Color fundus image. 1932 by 1932 pixels — 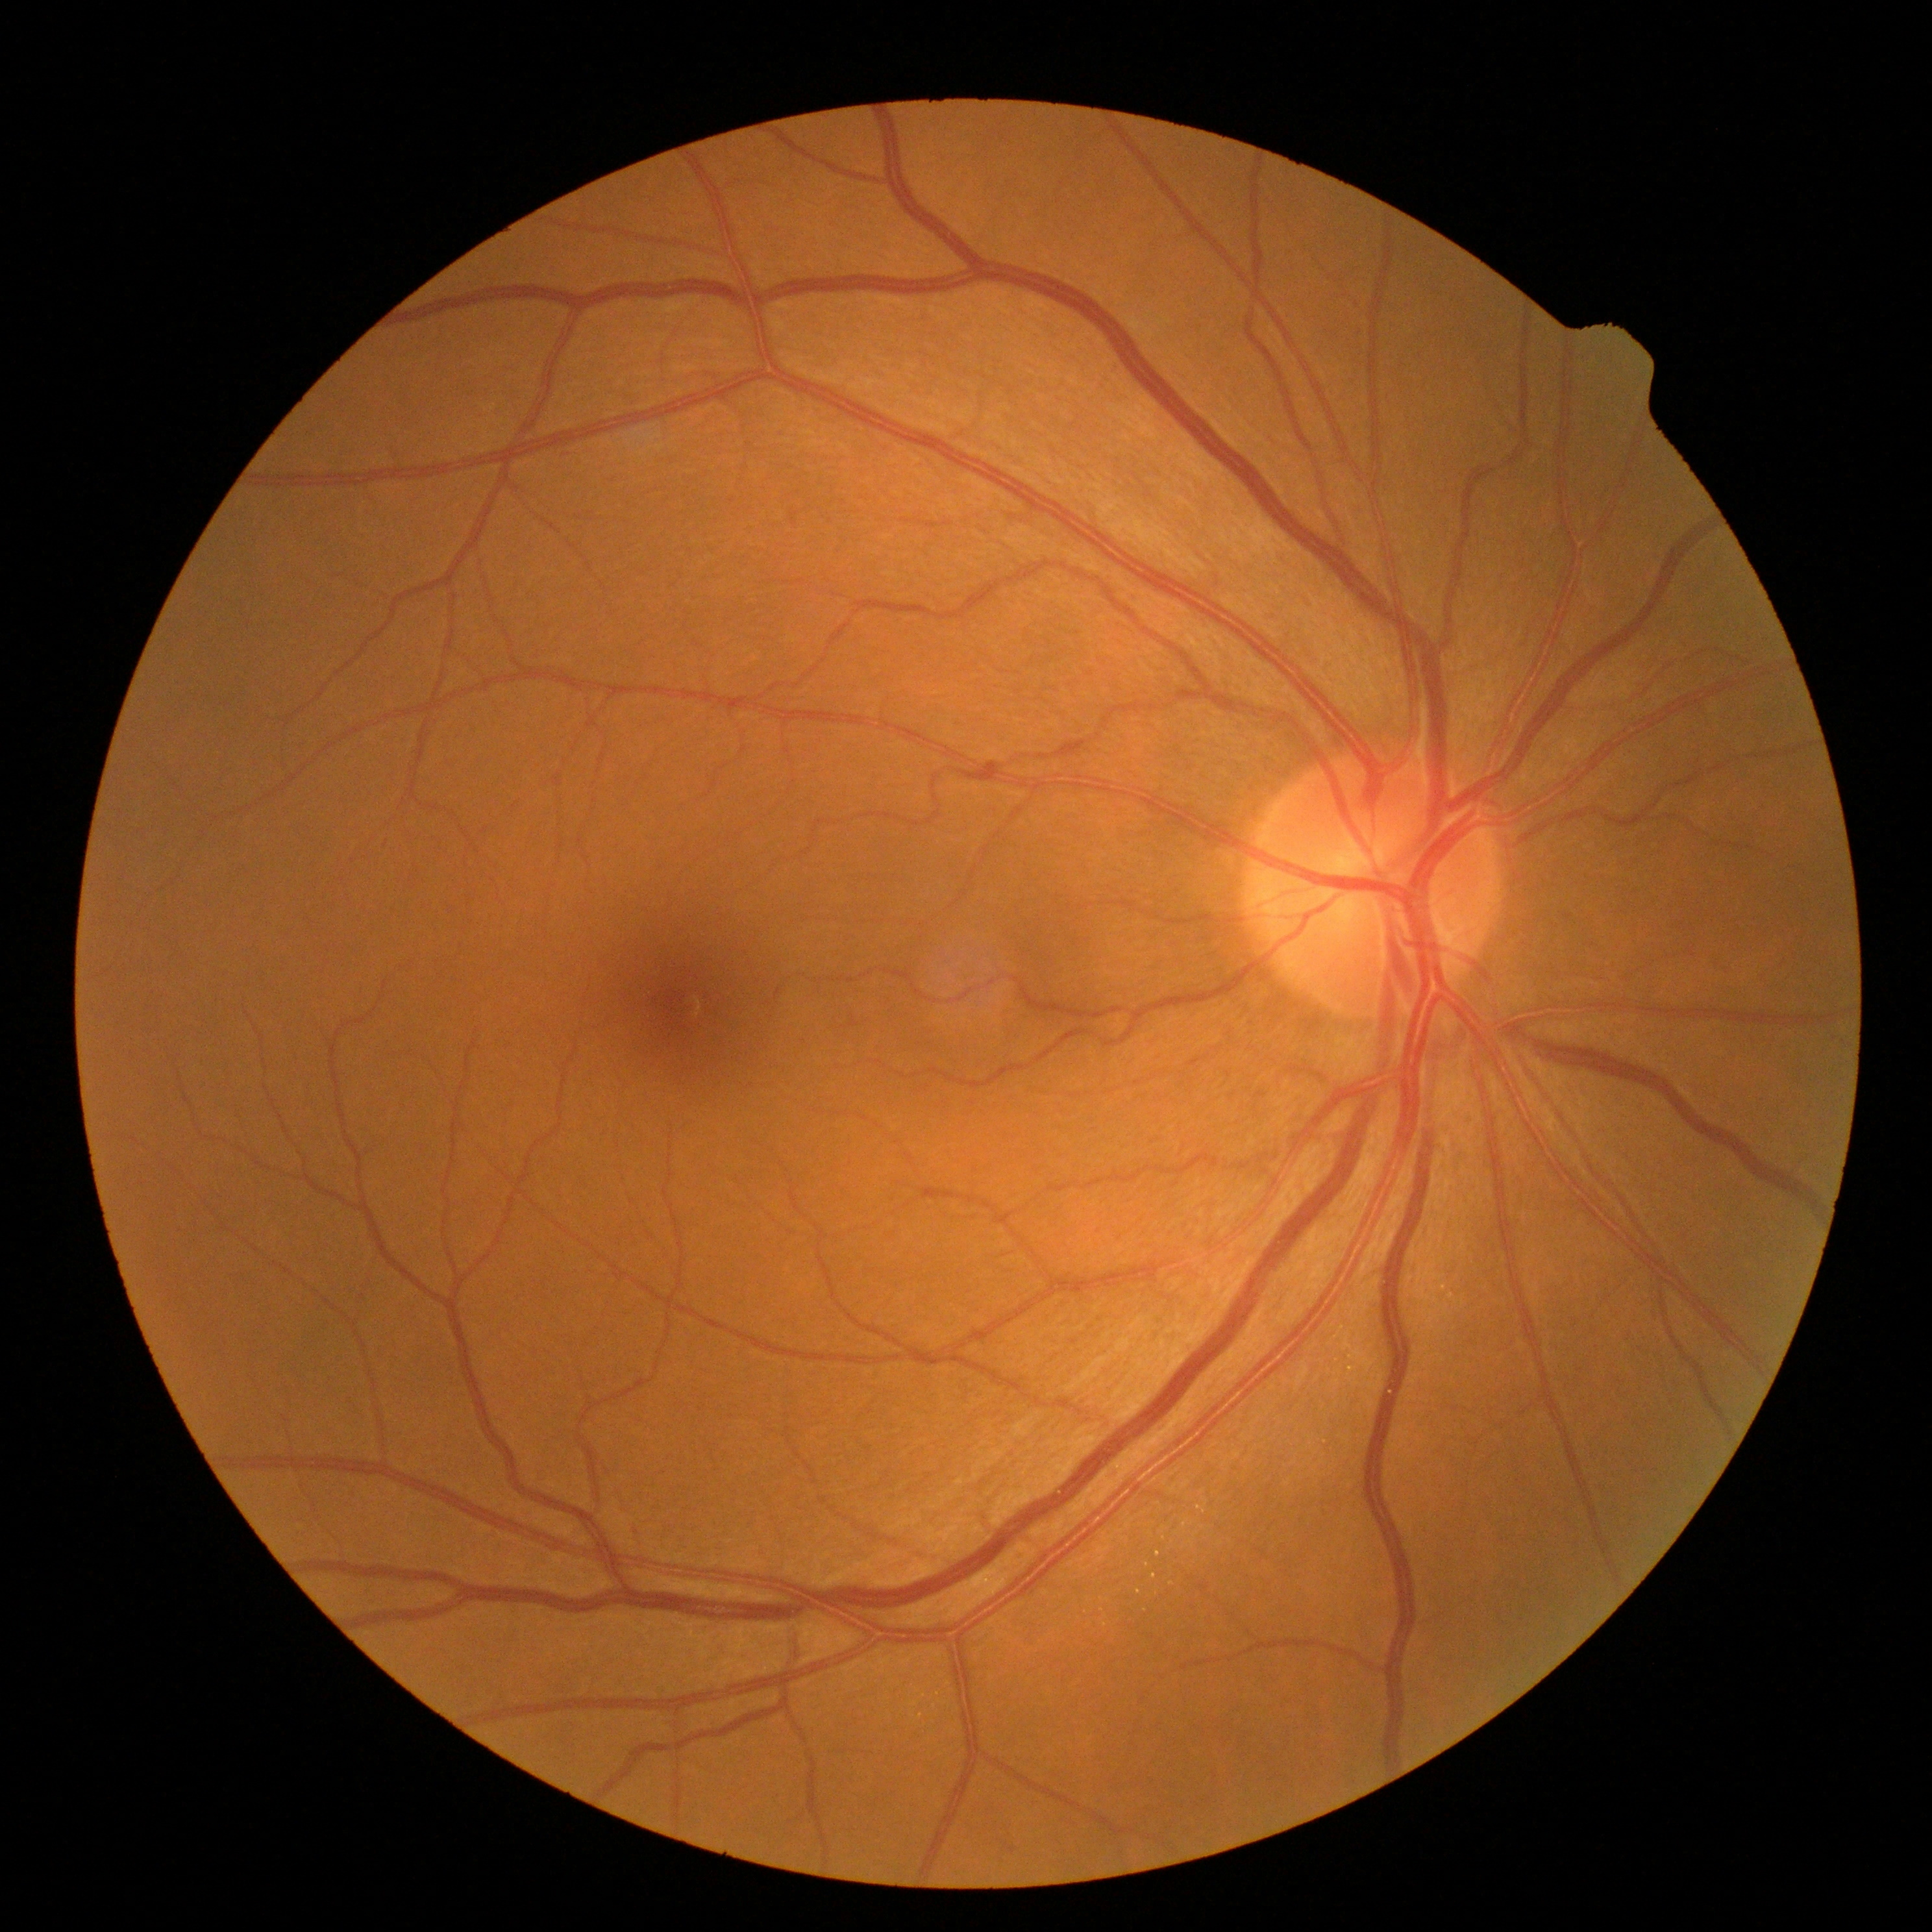 DR stage is no apparent retinopathy (grade 0).